45° FOV. 1932x1916
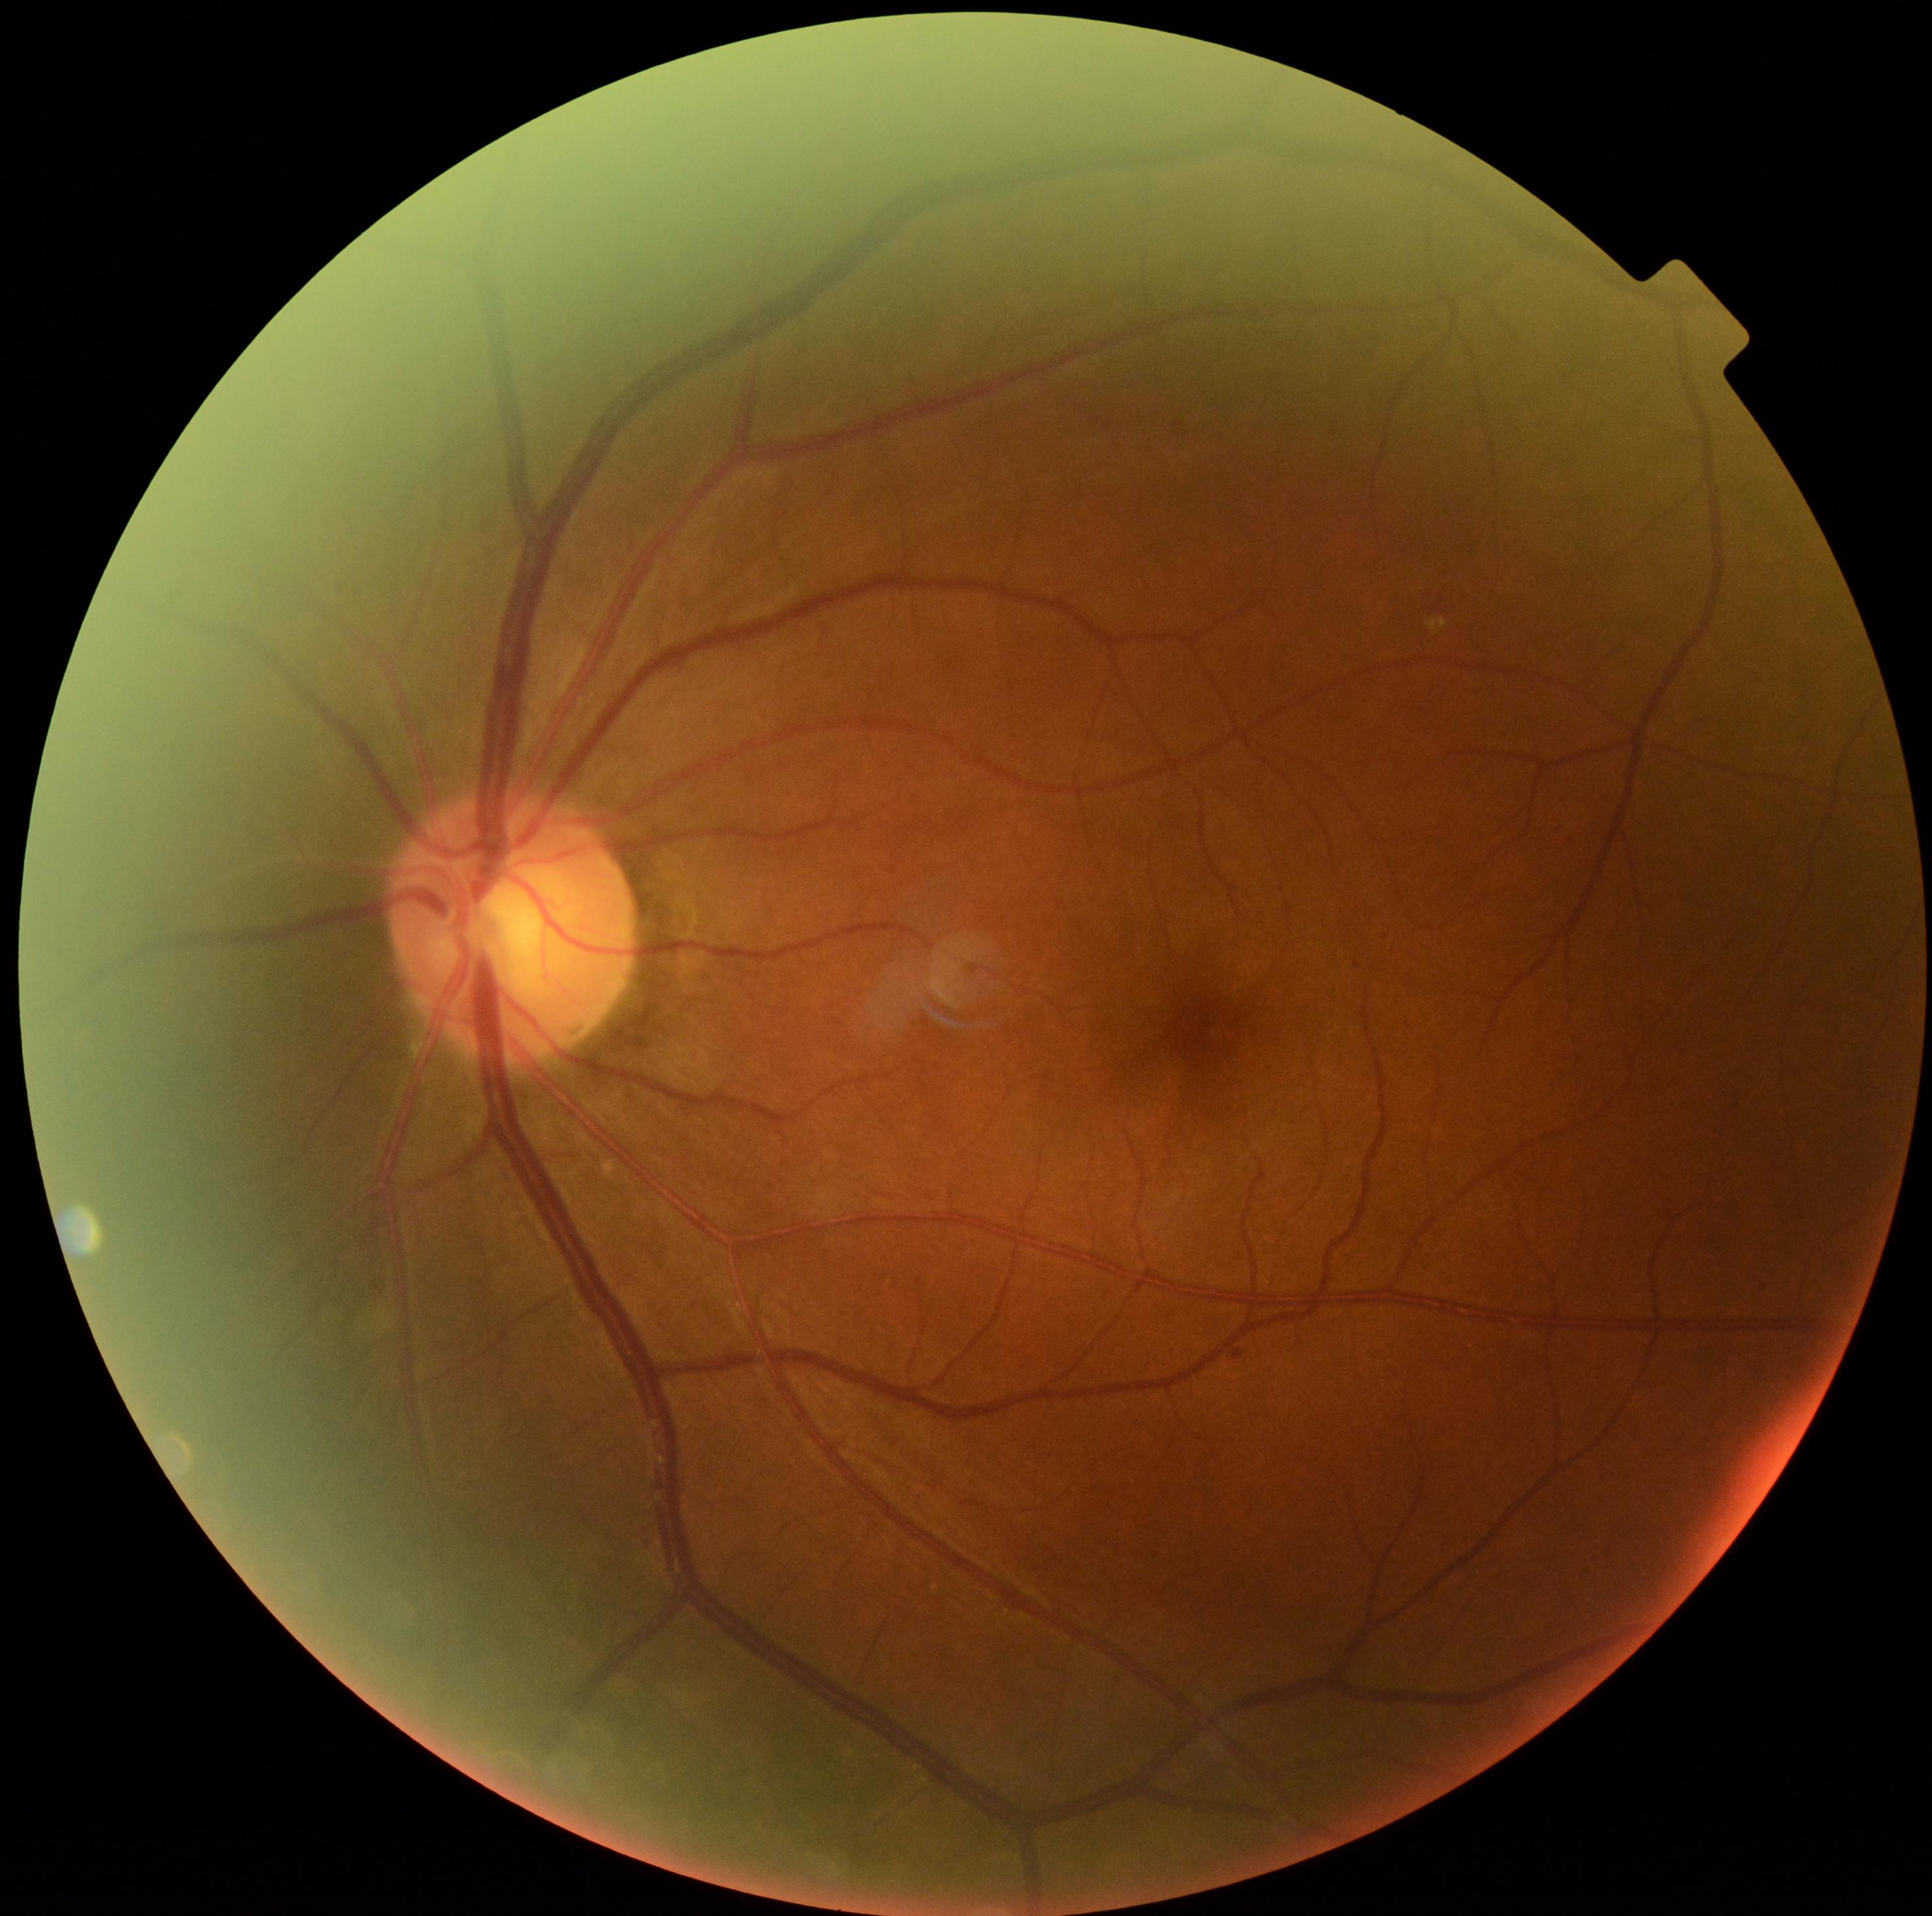

Diabetic retinopathy (DR) is mild NPDR (grade 1) — presence of microaneurysms only.